2212x1672 · 45° FOV.
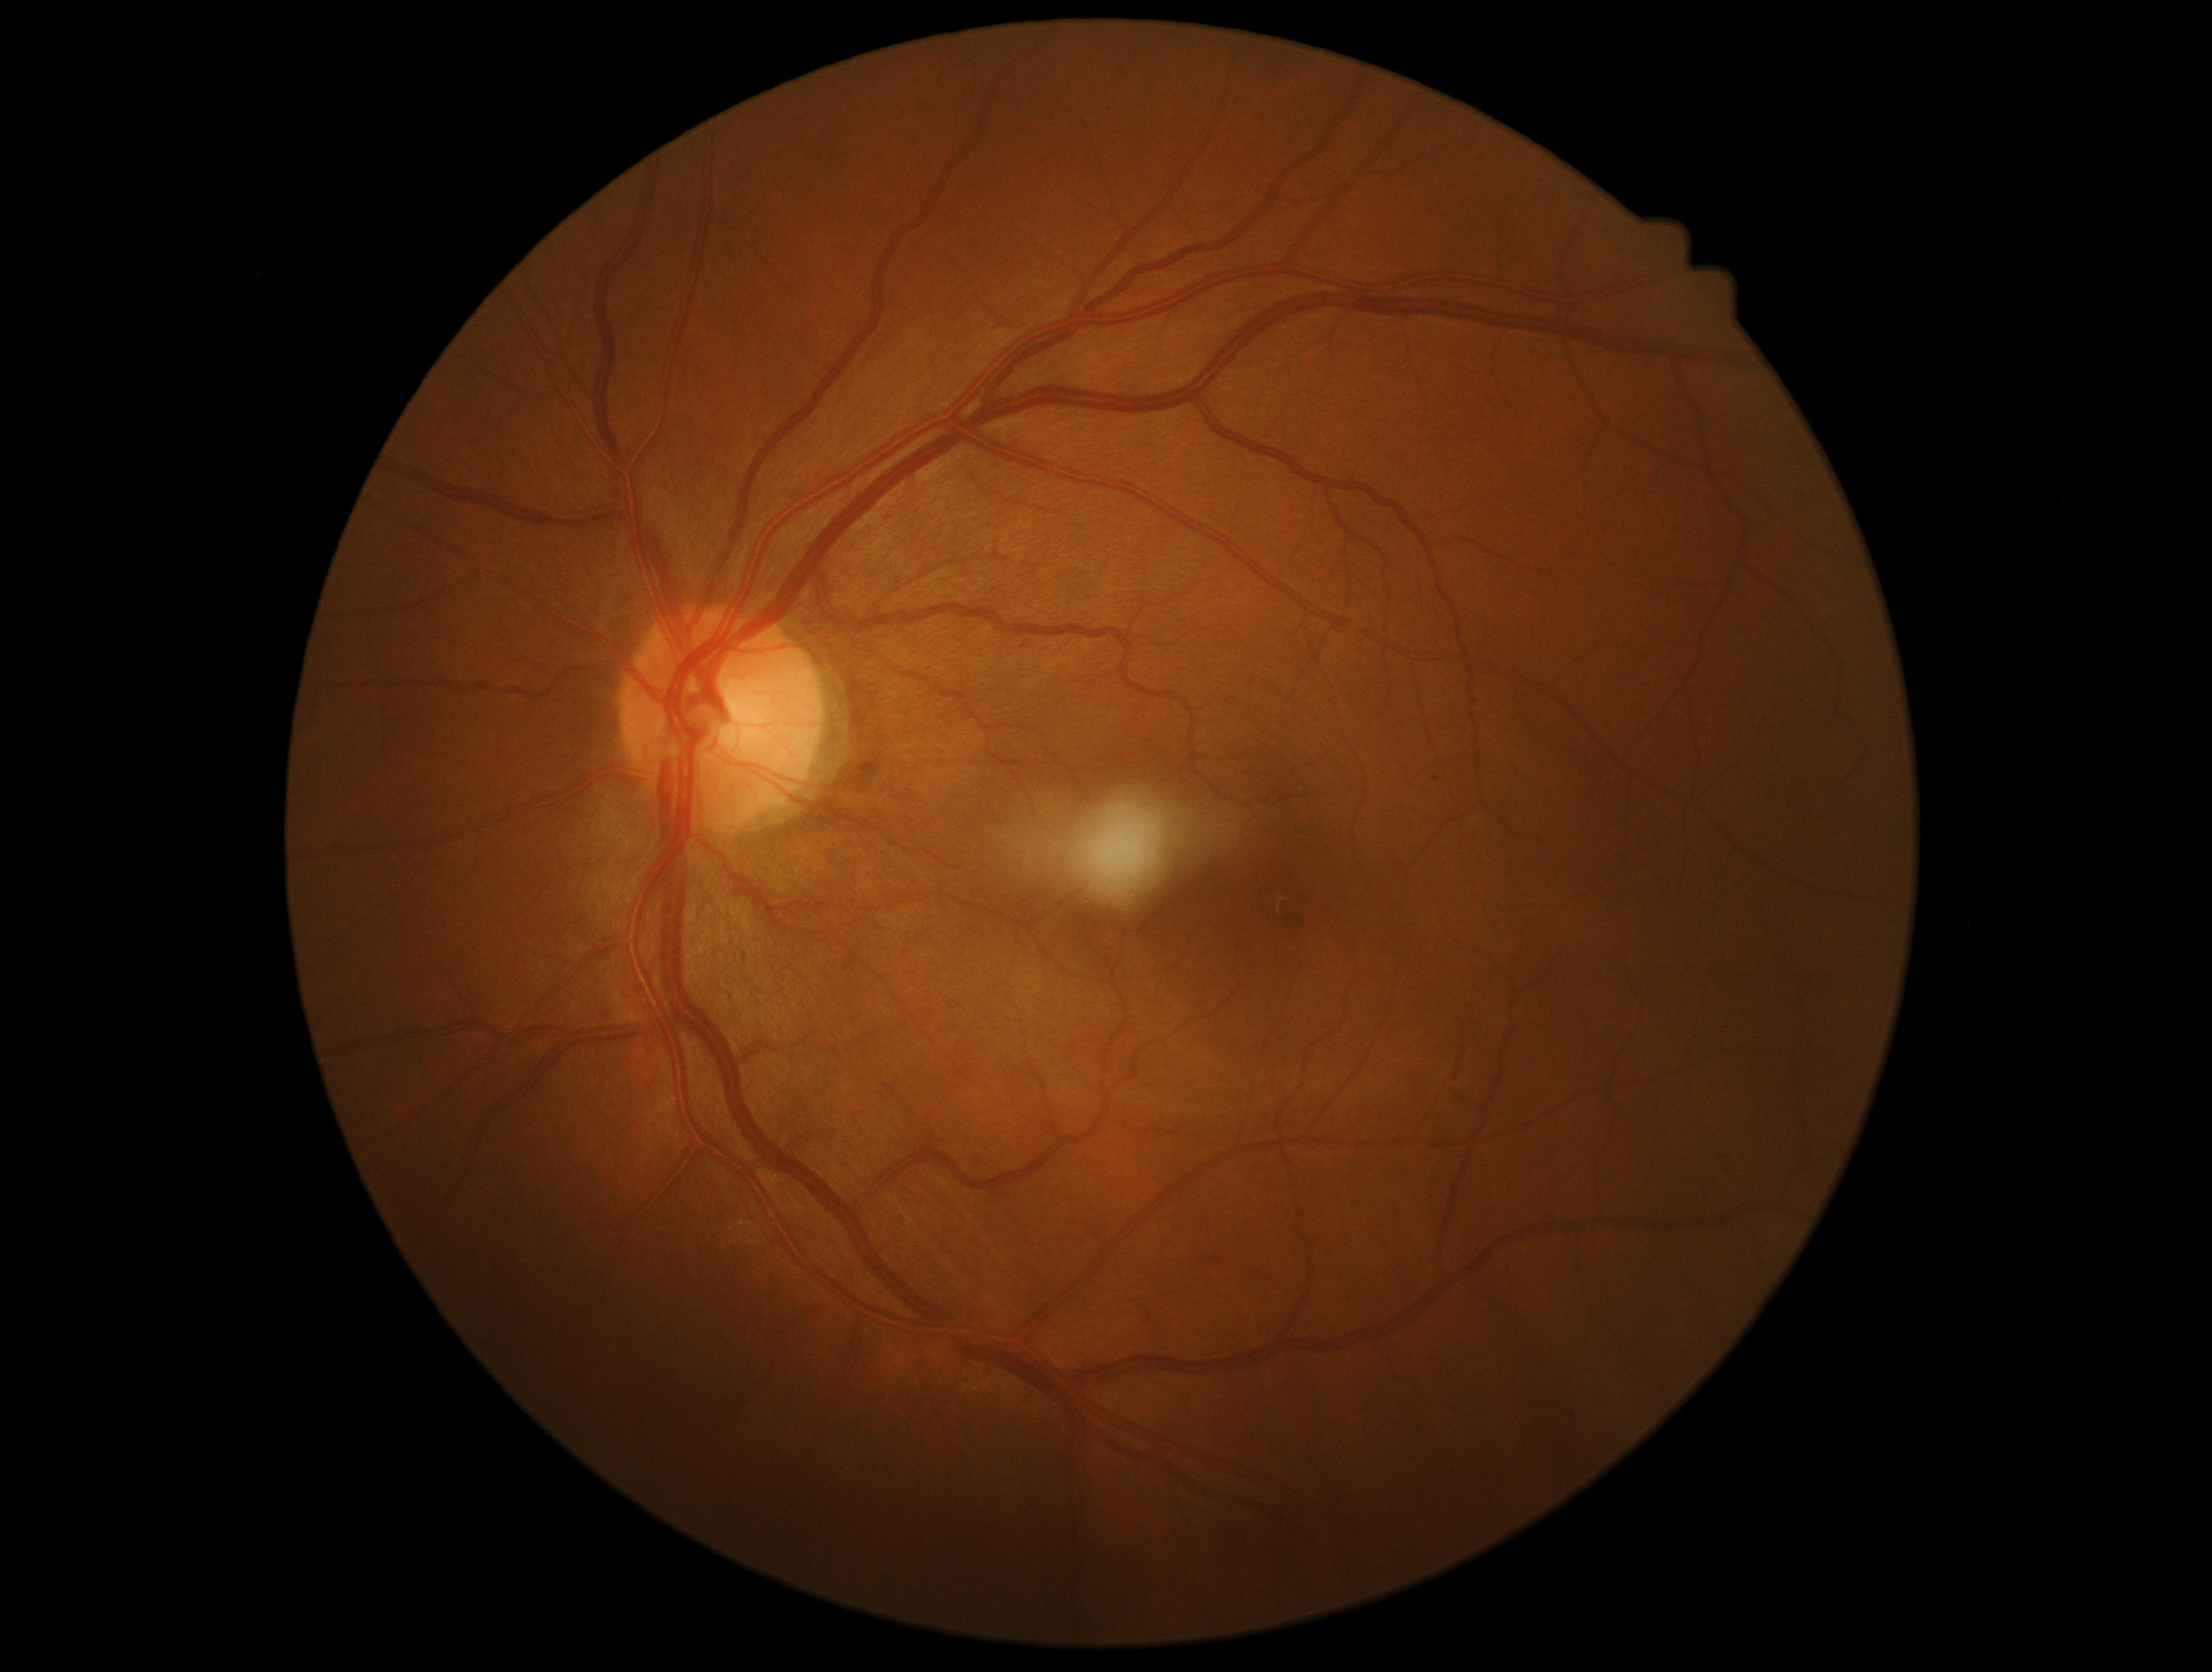 {
  "dr_grade": "1/4",
  "dr_category": "non-proliferative diabetic retinopathy"
}